Wide-field fundus photograph from neonatal ROP screening; camera: Natus RetCam Envision (130° FOV):
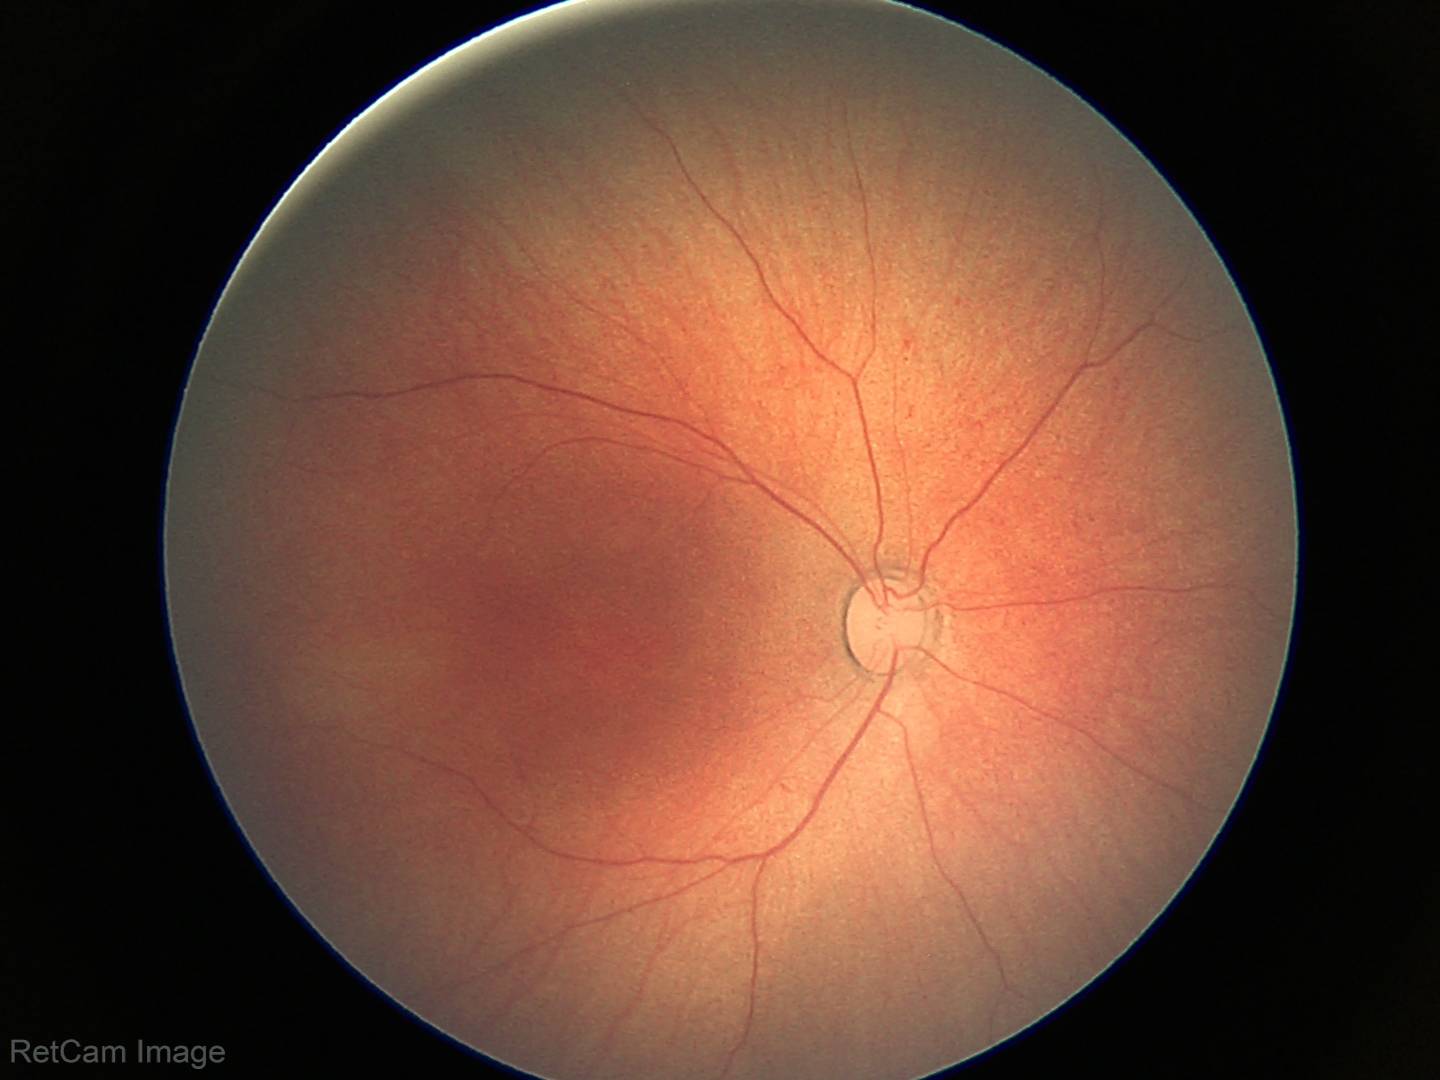

Finding = normal